Retinal fundus photograph. Nonmydriatic — 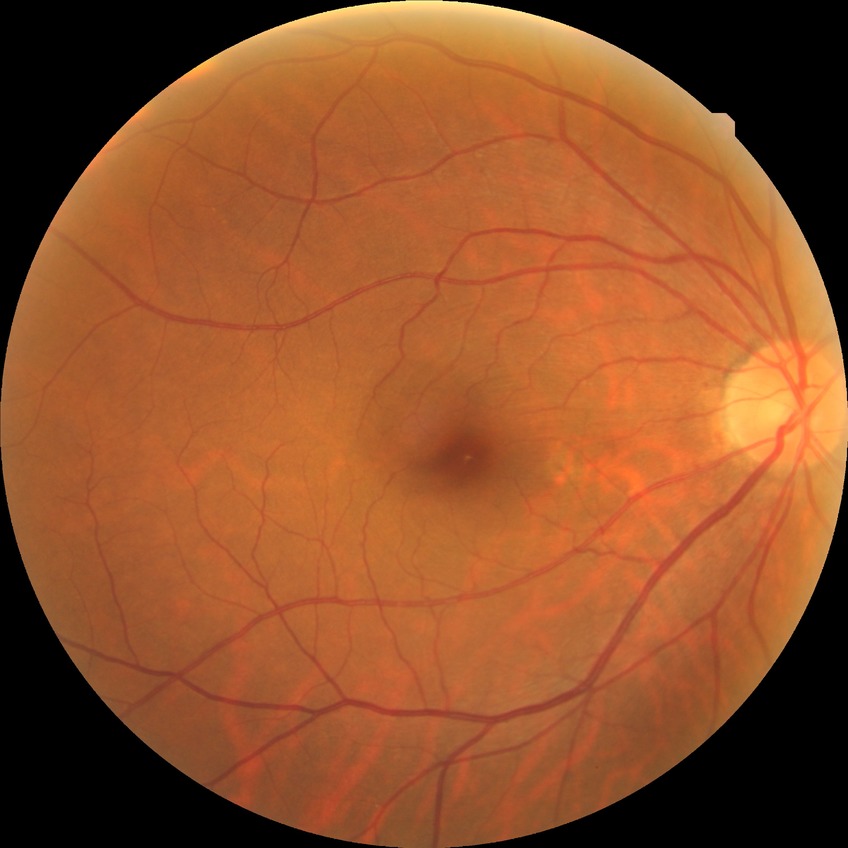
Findings:
- DR impression: no apparent DR
- DR severity: NDR